Image size 1659x2212.
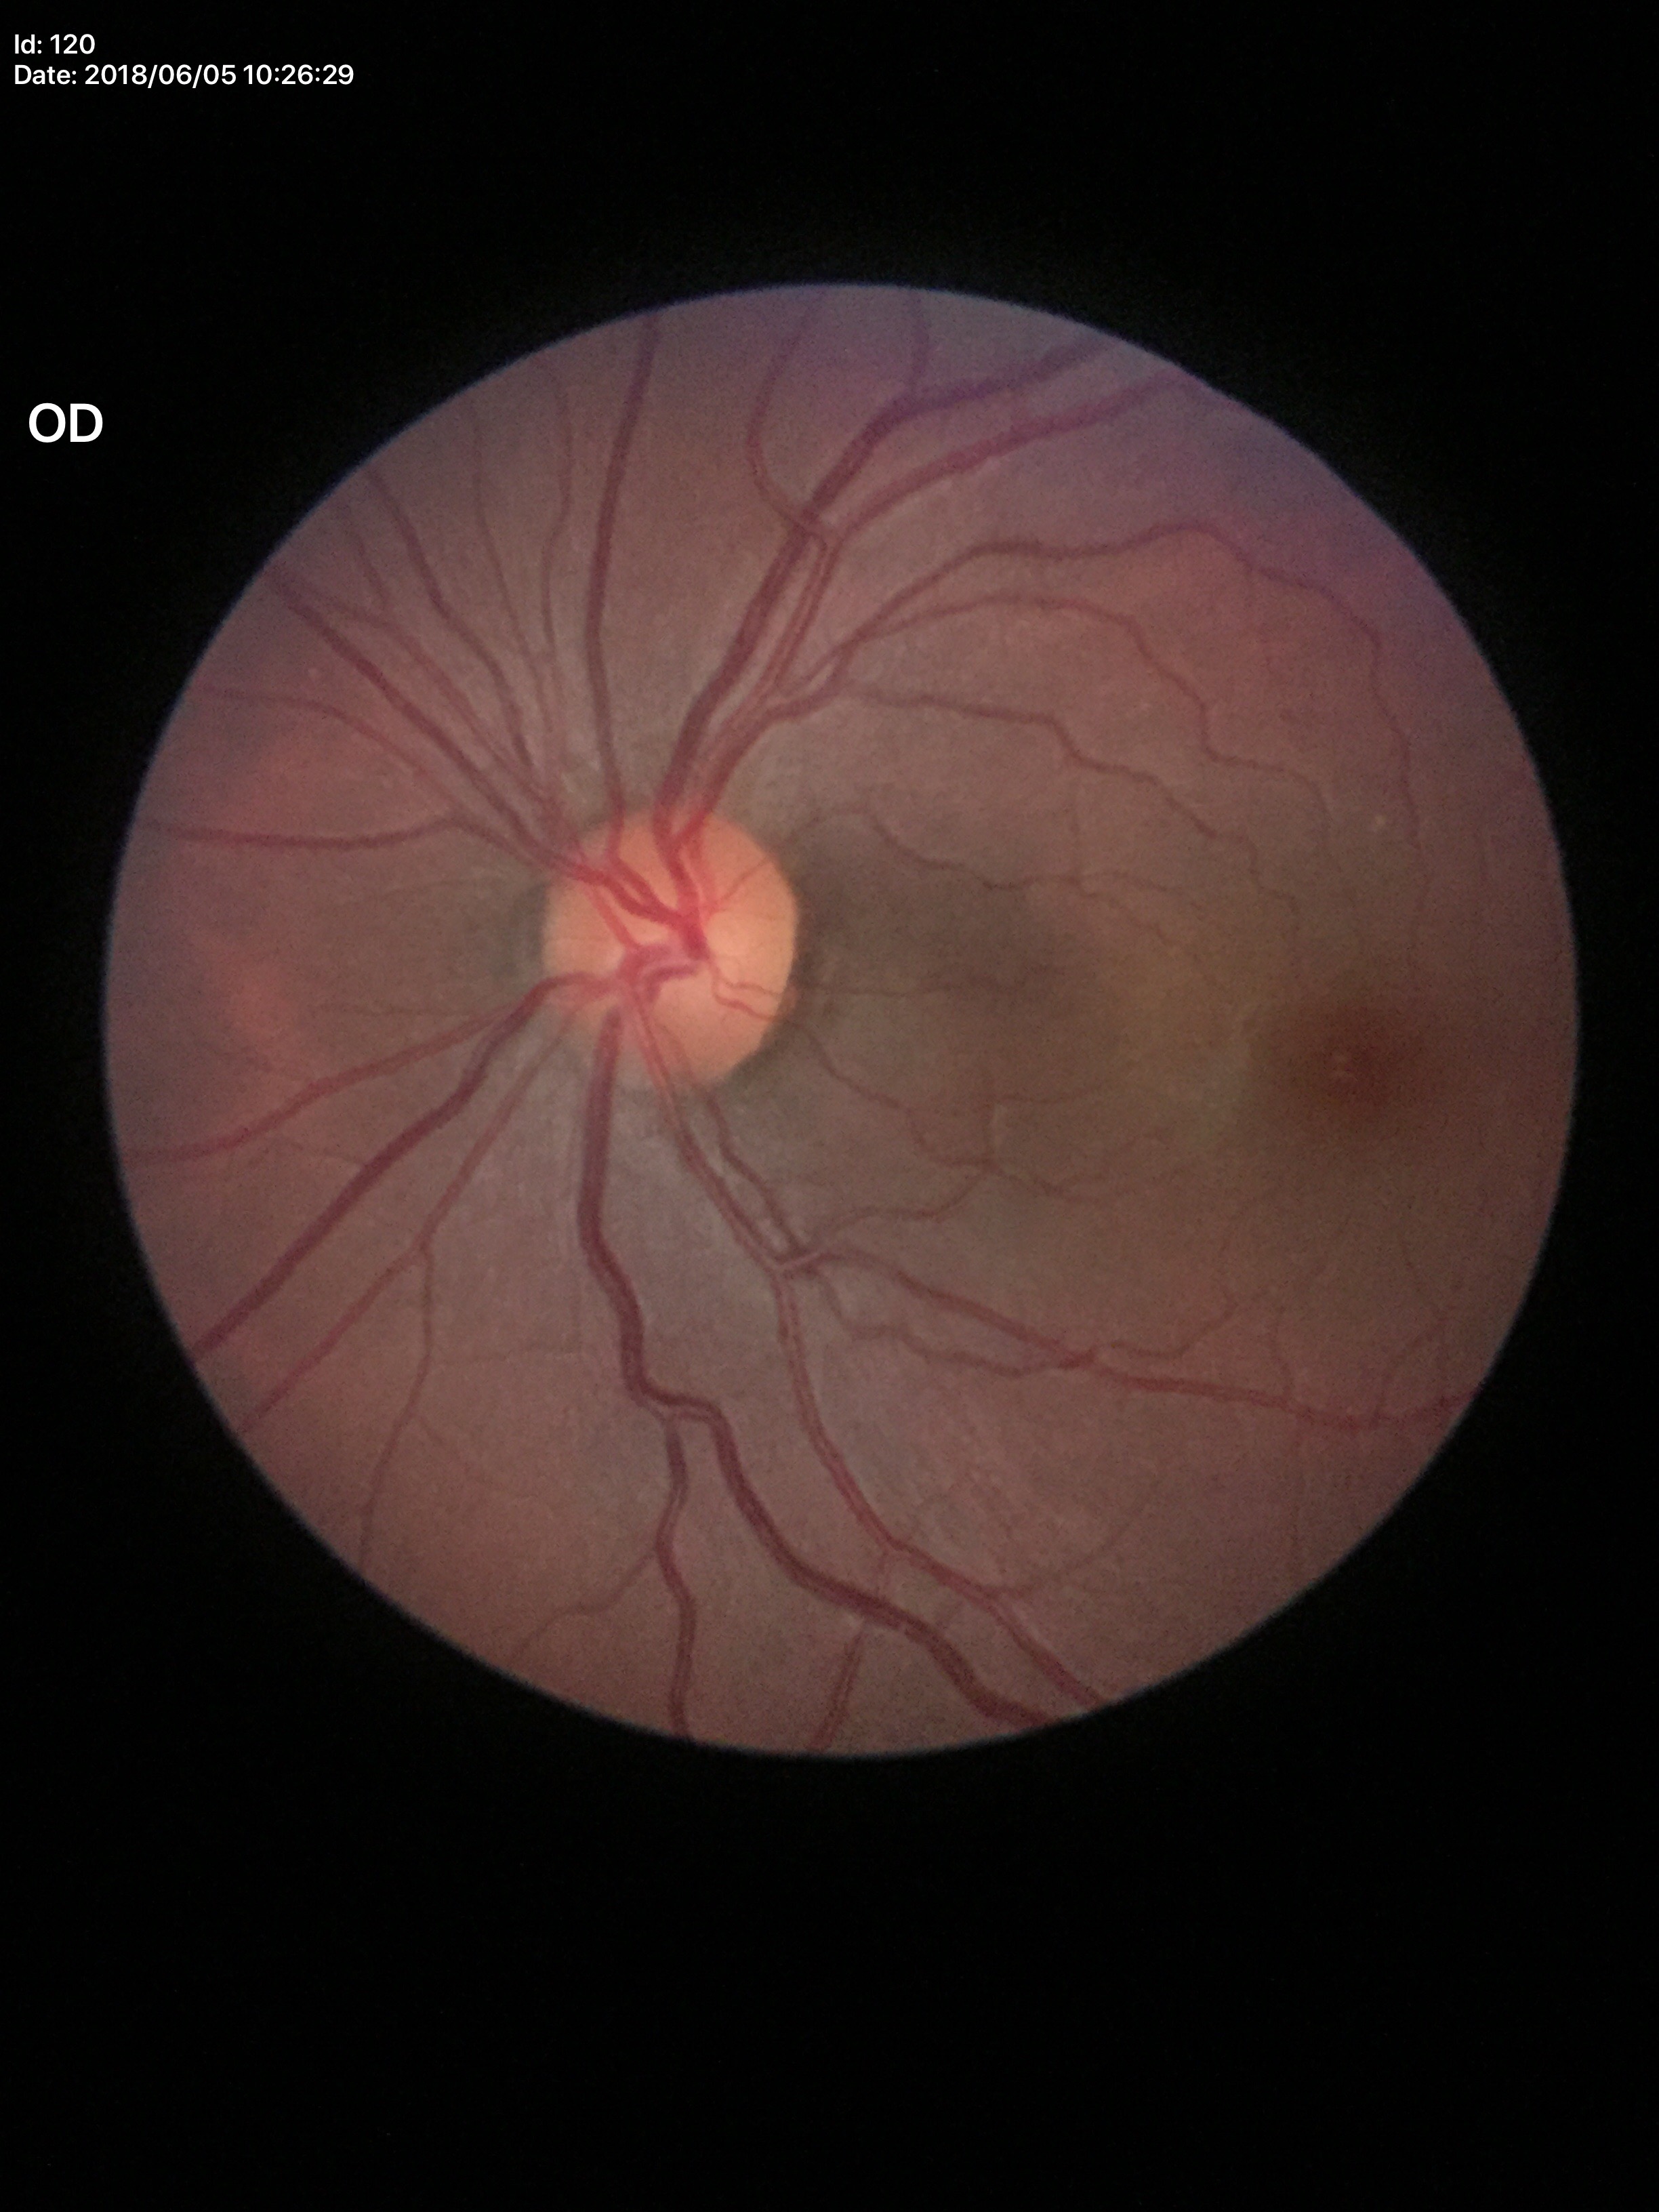
Q: Glaucoma screening result?
A: negative
Q: What is the vertical cup-to-disc ratio?
A: 0.46